Image size 2352x1568 · retinal fundus photograph:
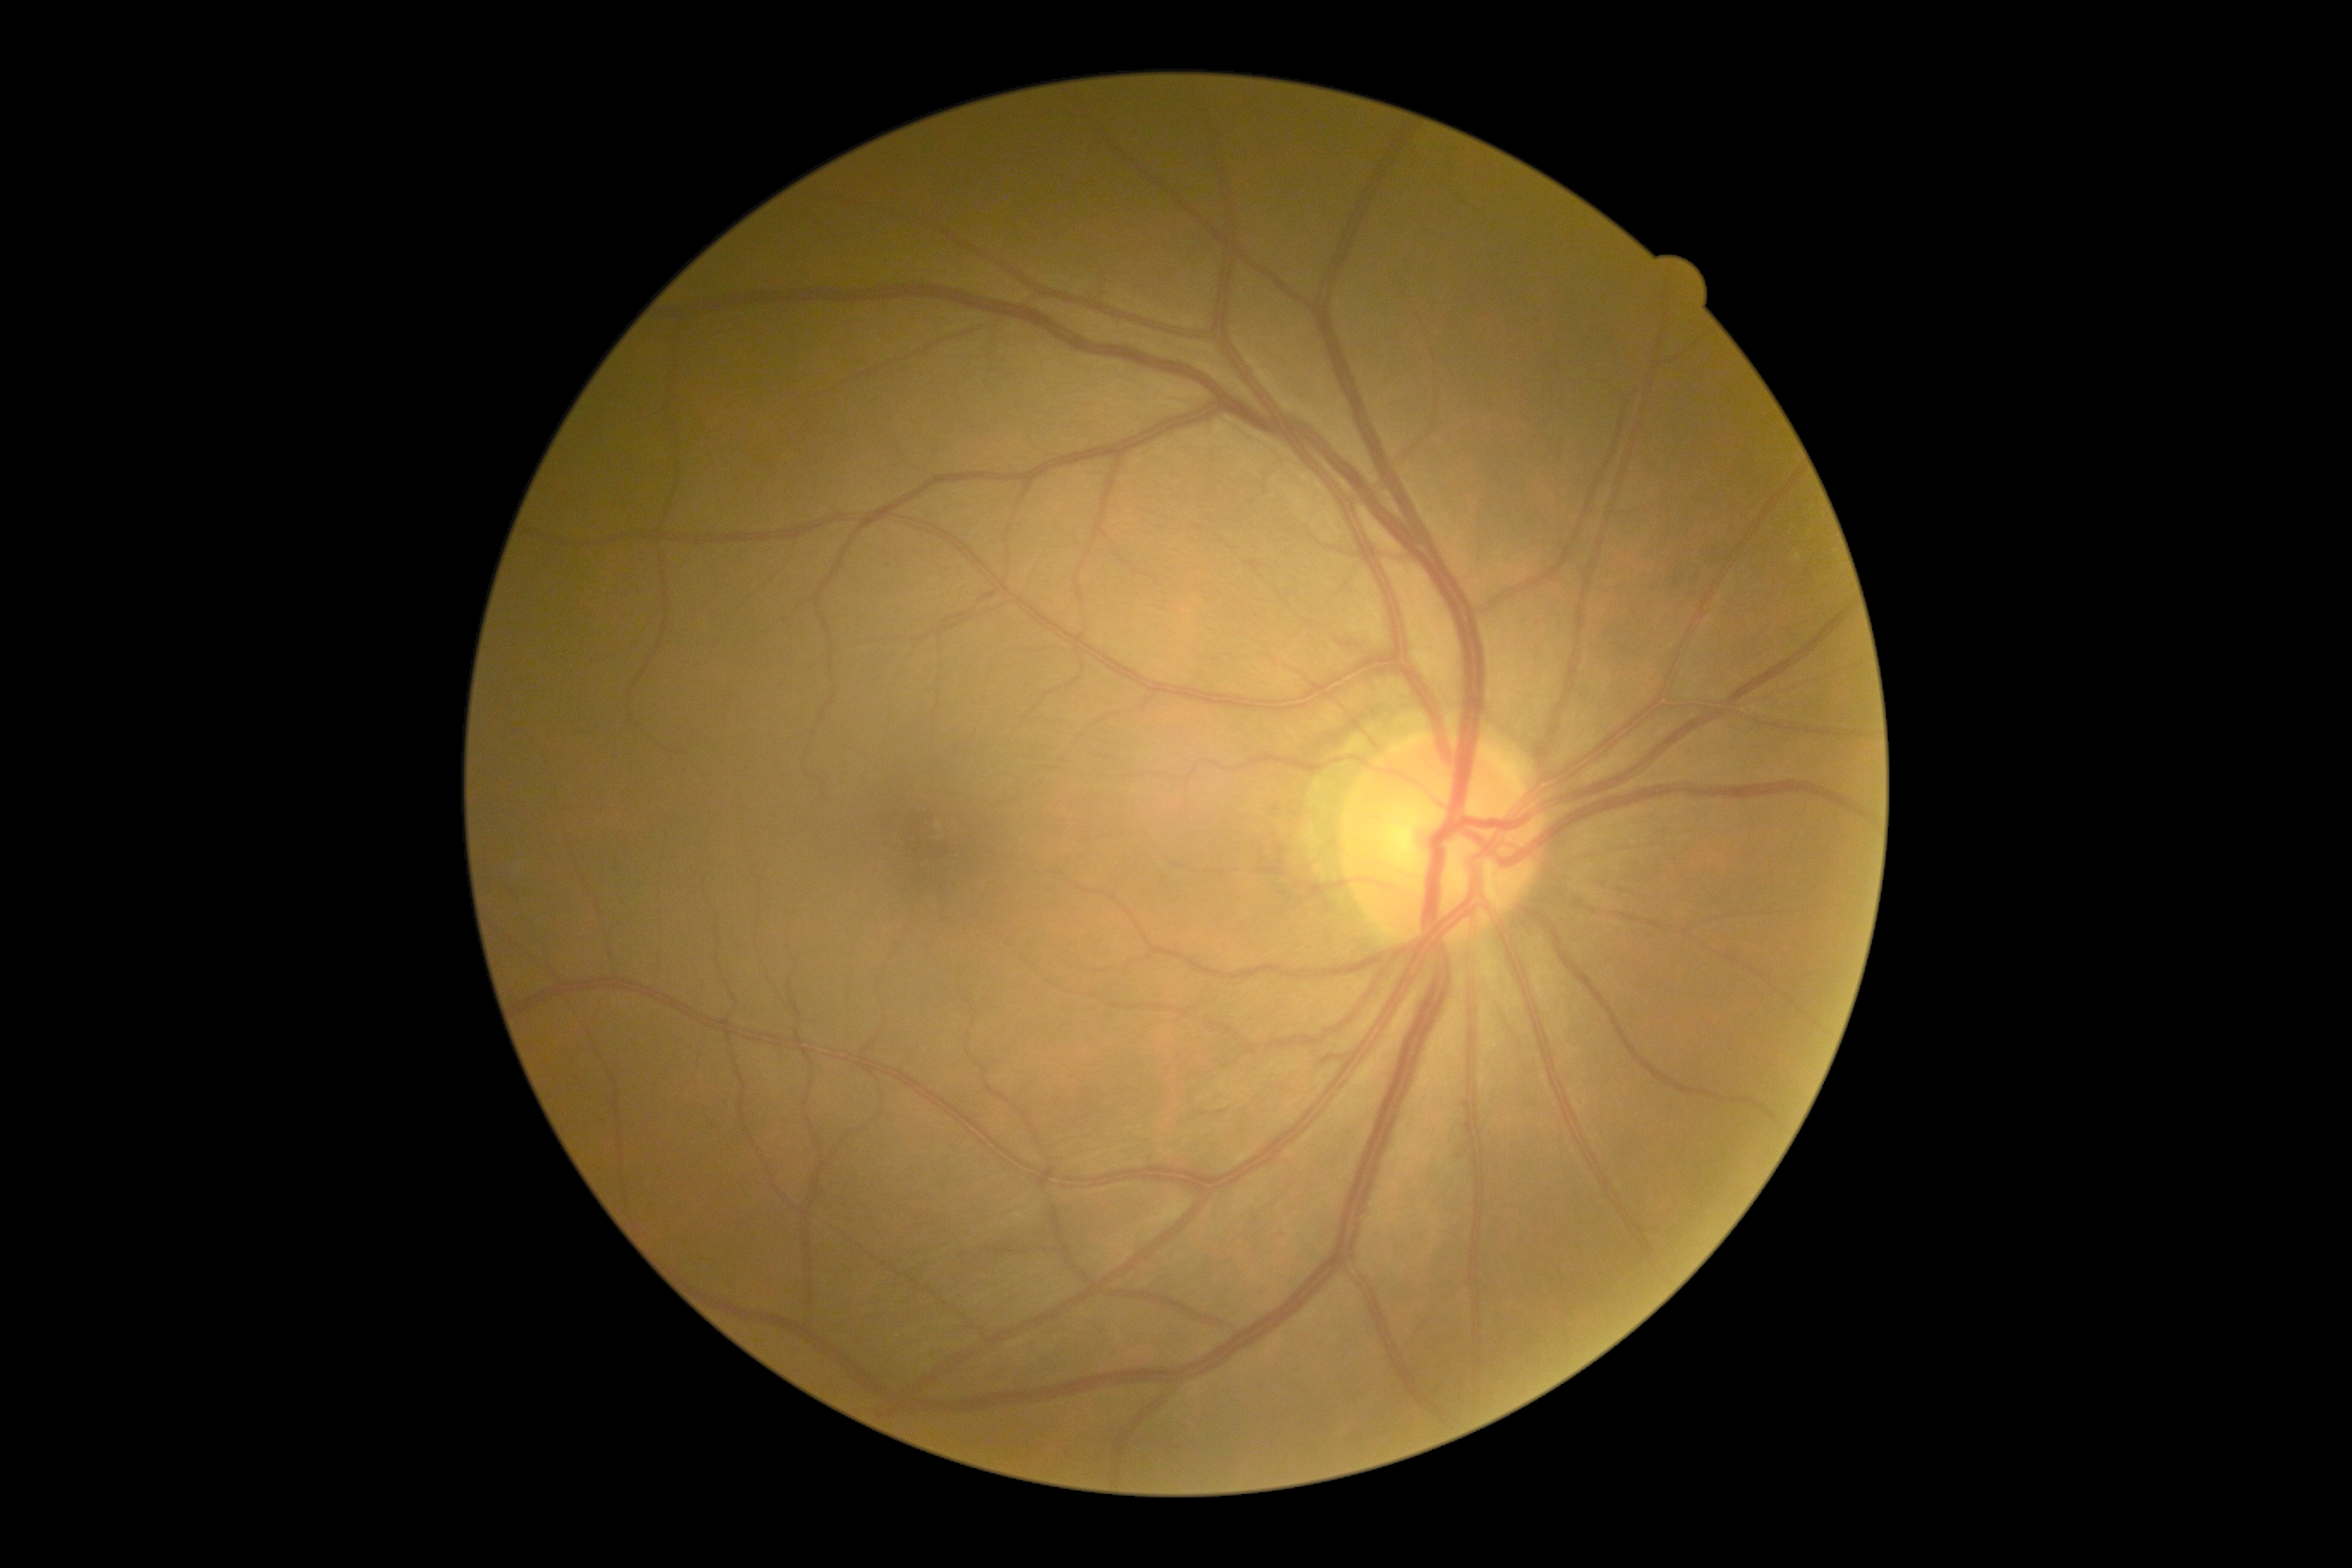
Diabetic retinopathy severity: grade 0.